45° FOV, NIDEK AFC-230, image size 848x848, DR severity per modified Davis staging, without pupil dilation, color fundus photograph — 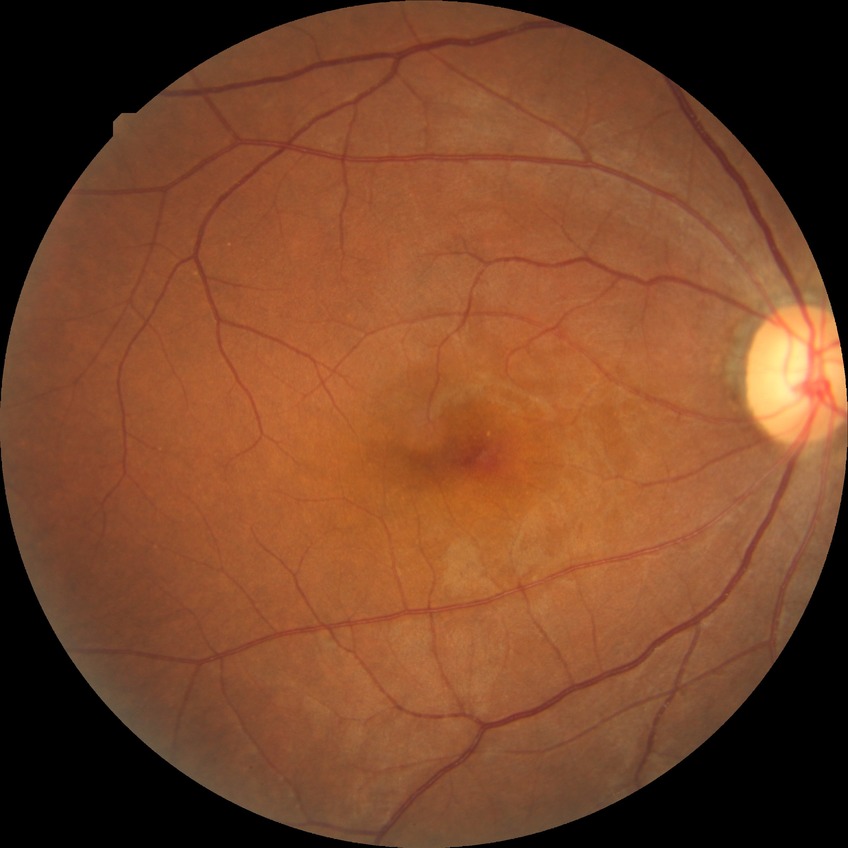
Diabetic retinopathy (DR) is no diabetic retinopathy (NDR).